Color fundus photograph
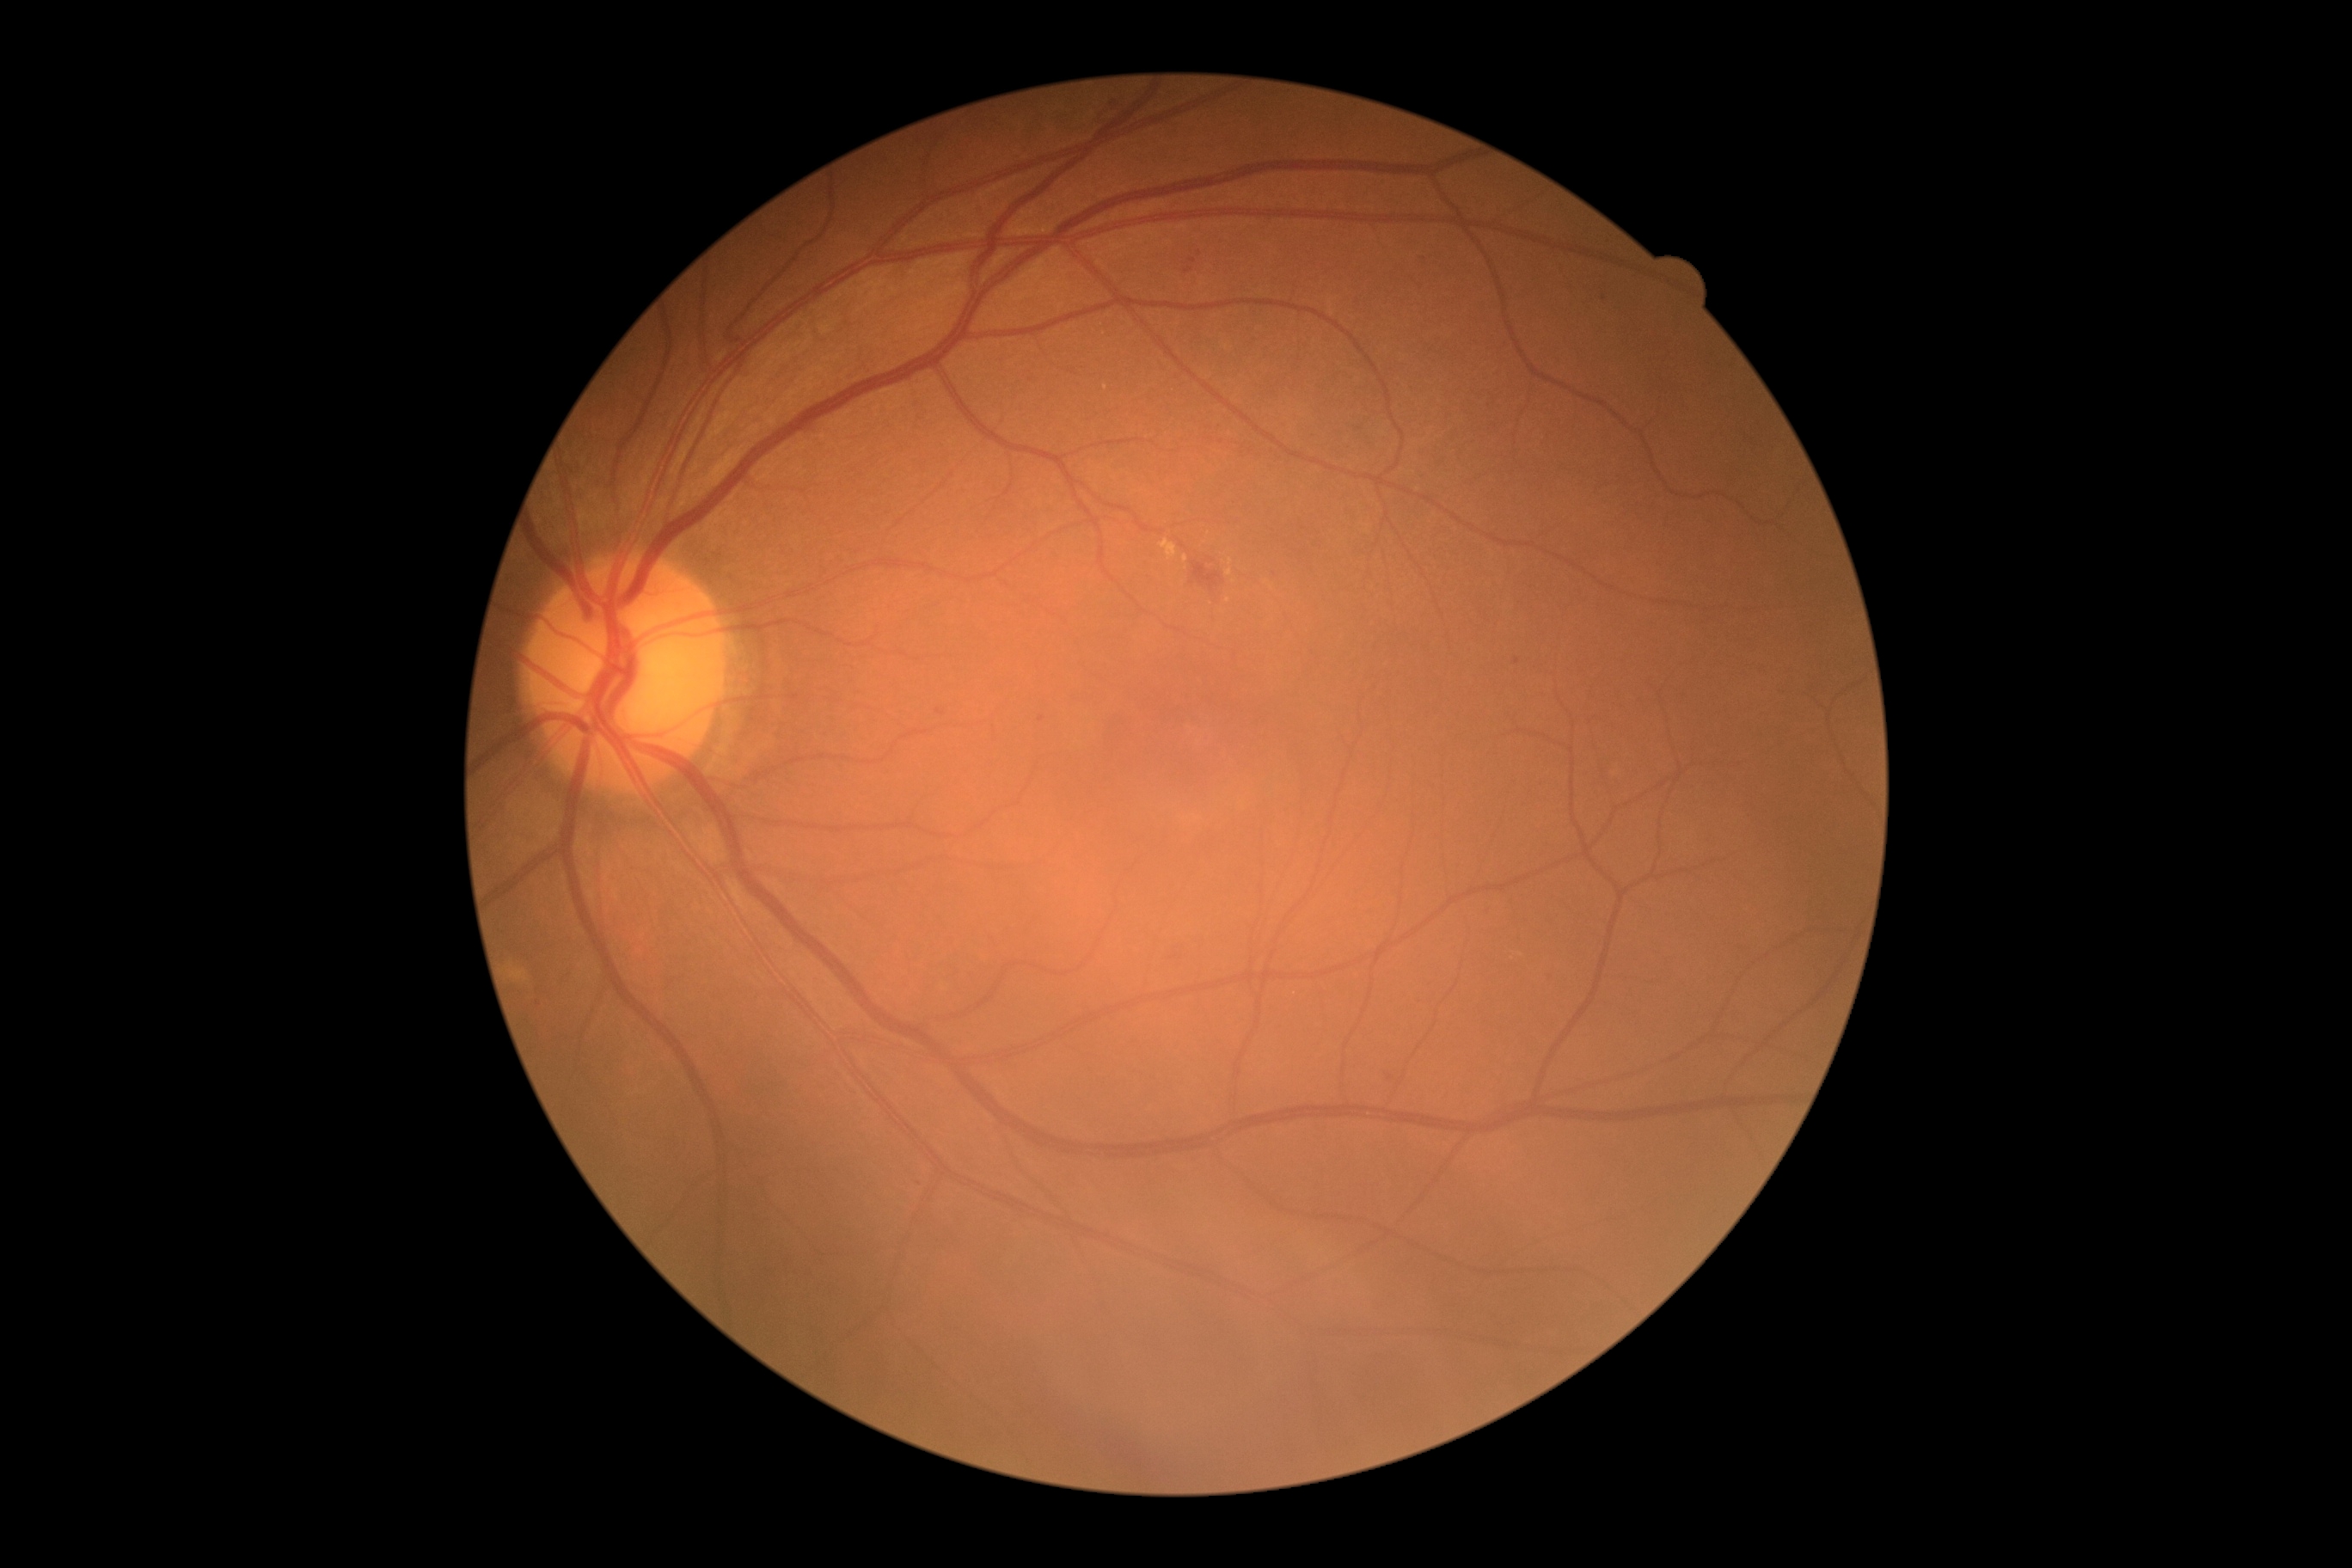

DR grade is moderate non-proliferative diabetic retinopathy (2).
The retinopathy is classified as non-proliferative diabetic retinopathy.